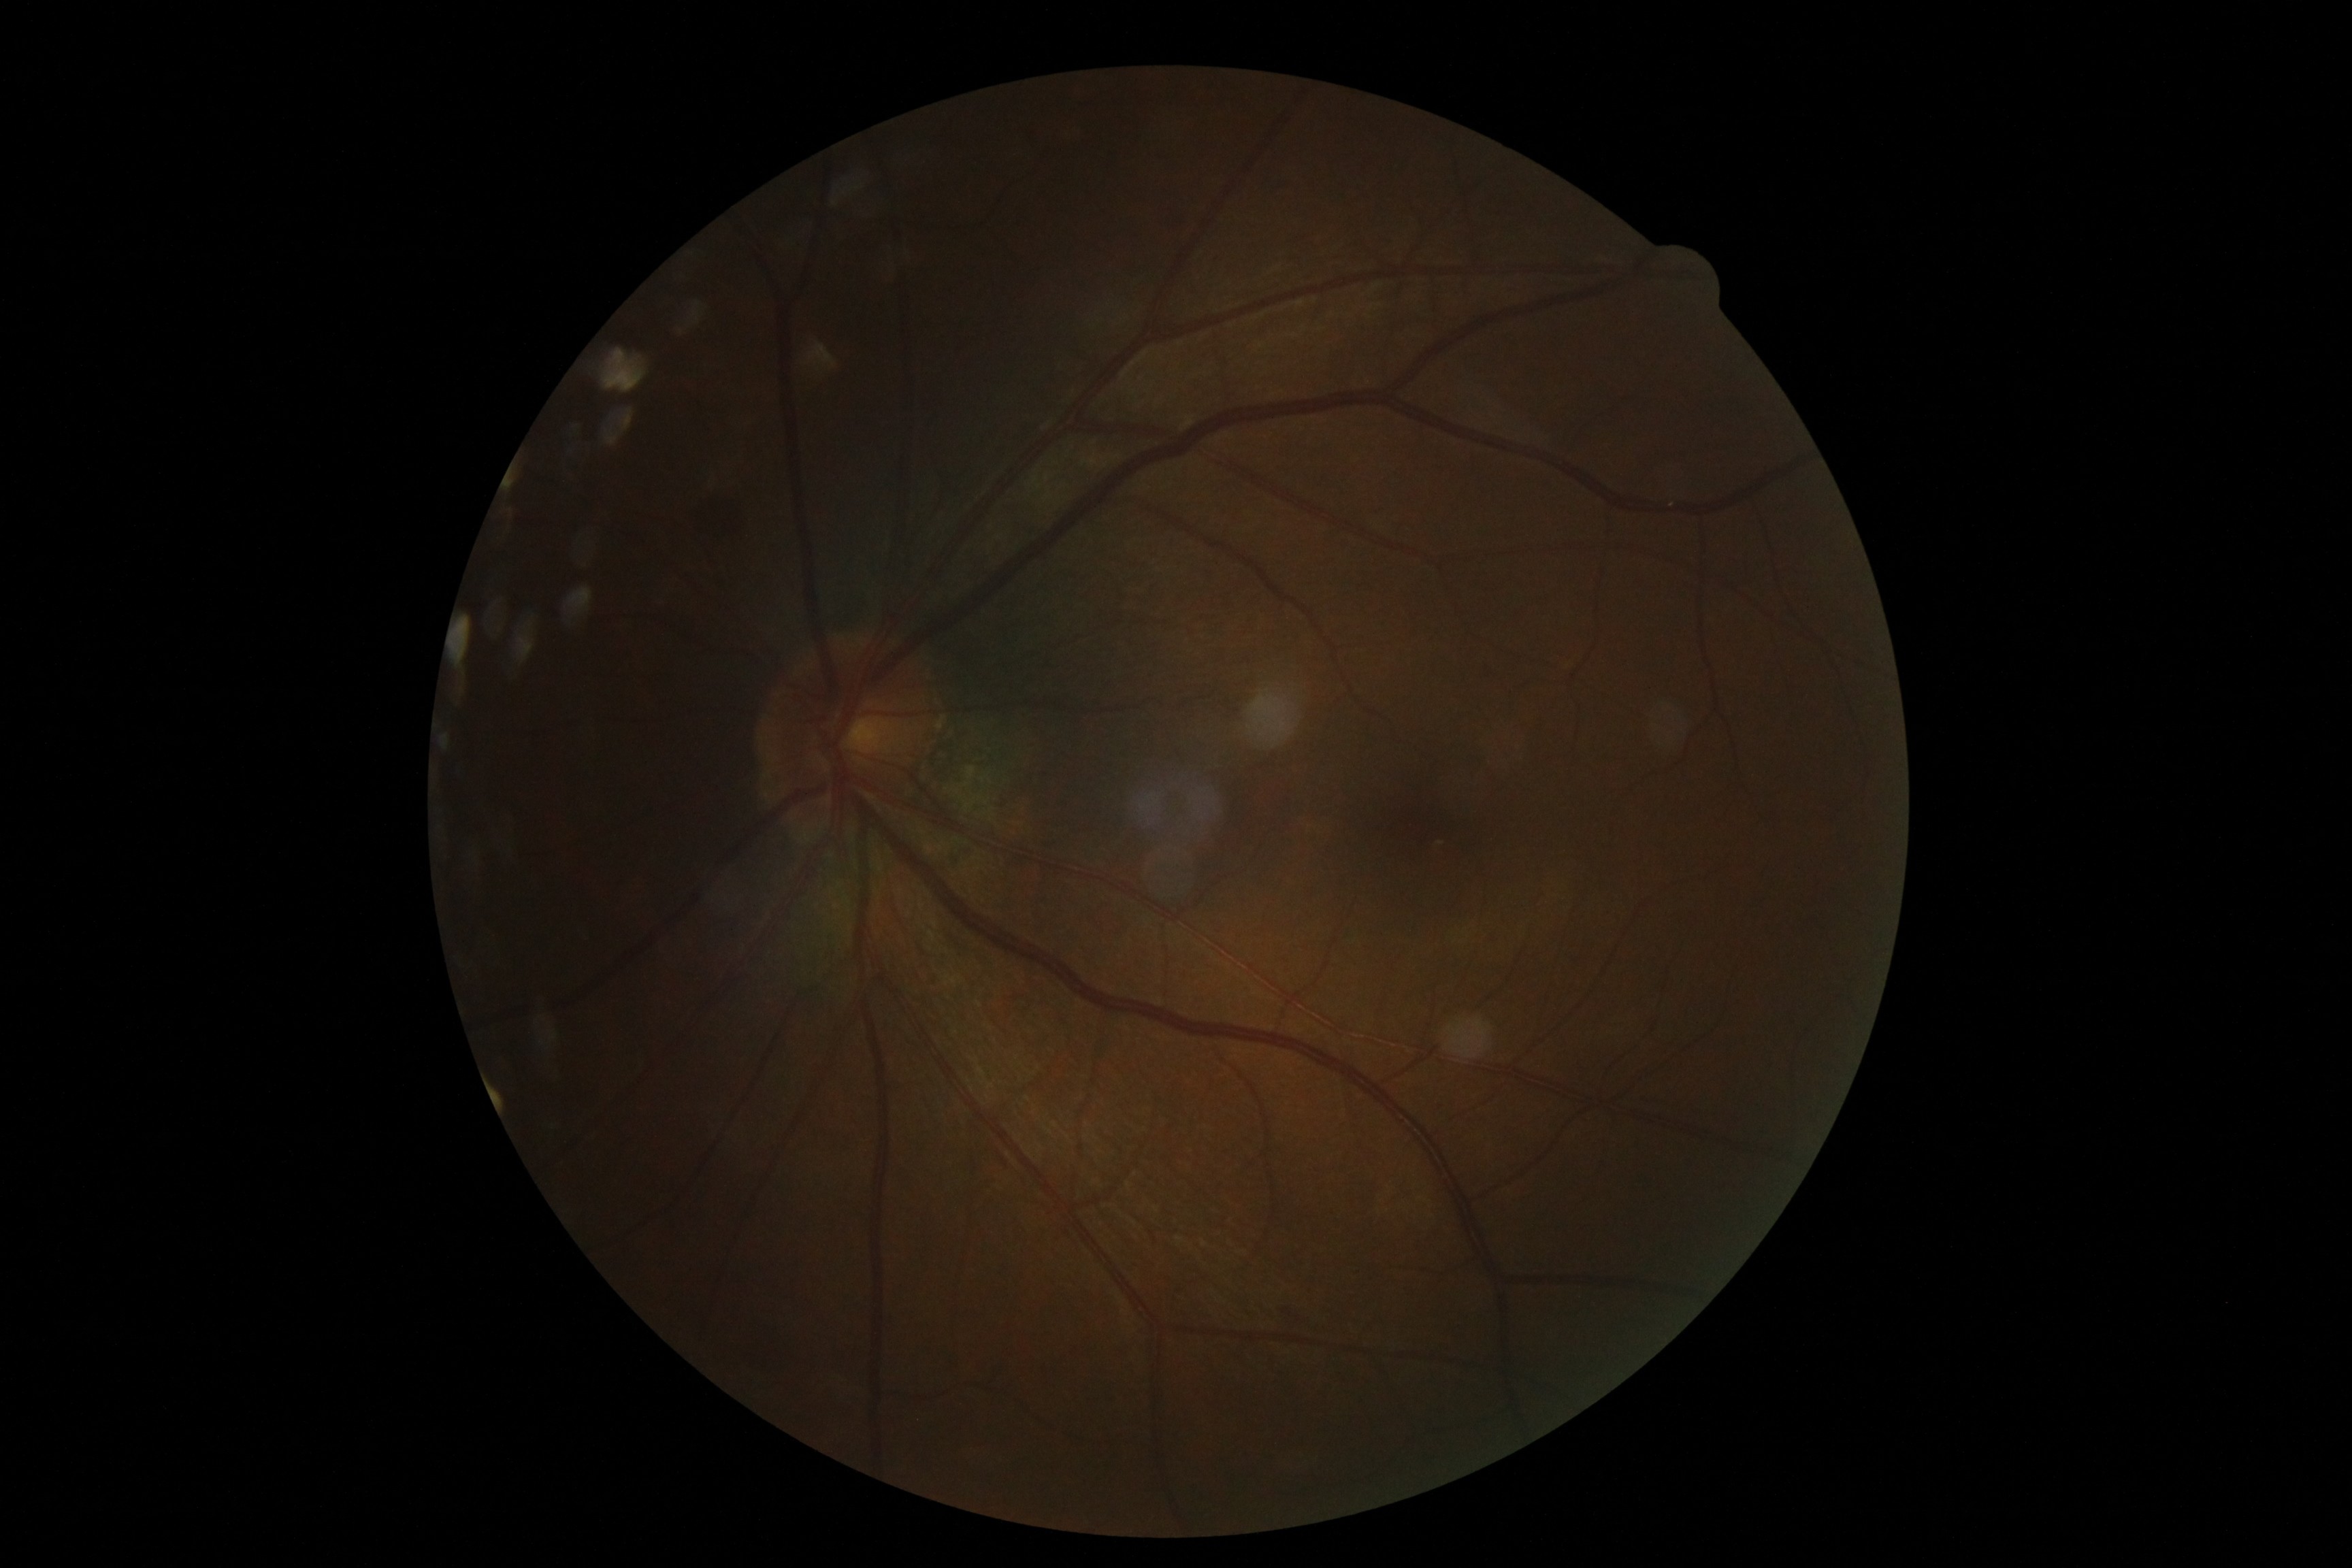
DR grade is moderate non-proliferative diabetic retinopathy (2). The retinopathy is classified as non-proliferative diabetic retinopathy.